1440 x 1080 pixels. Camera: Natus RetCam Envision (130° FOV). Pediatric retinal photograph (wide-field) — 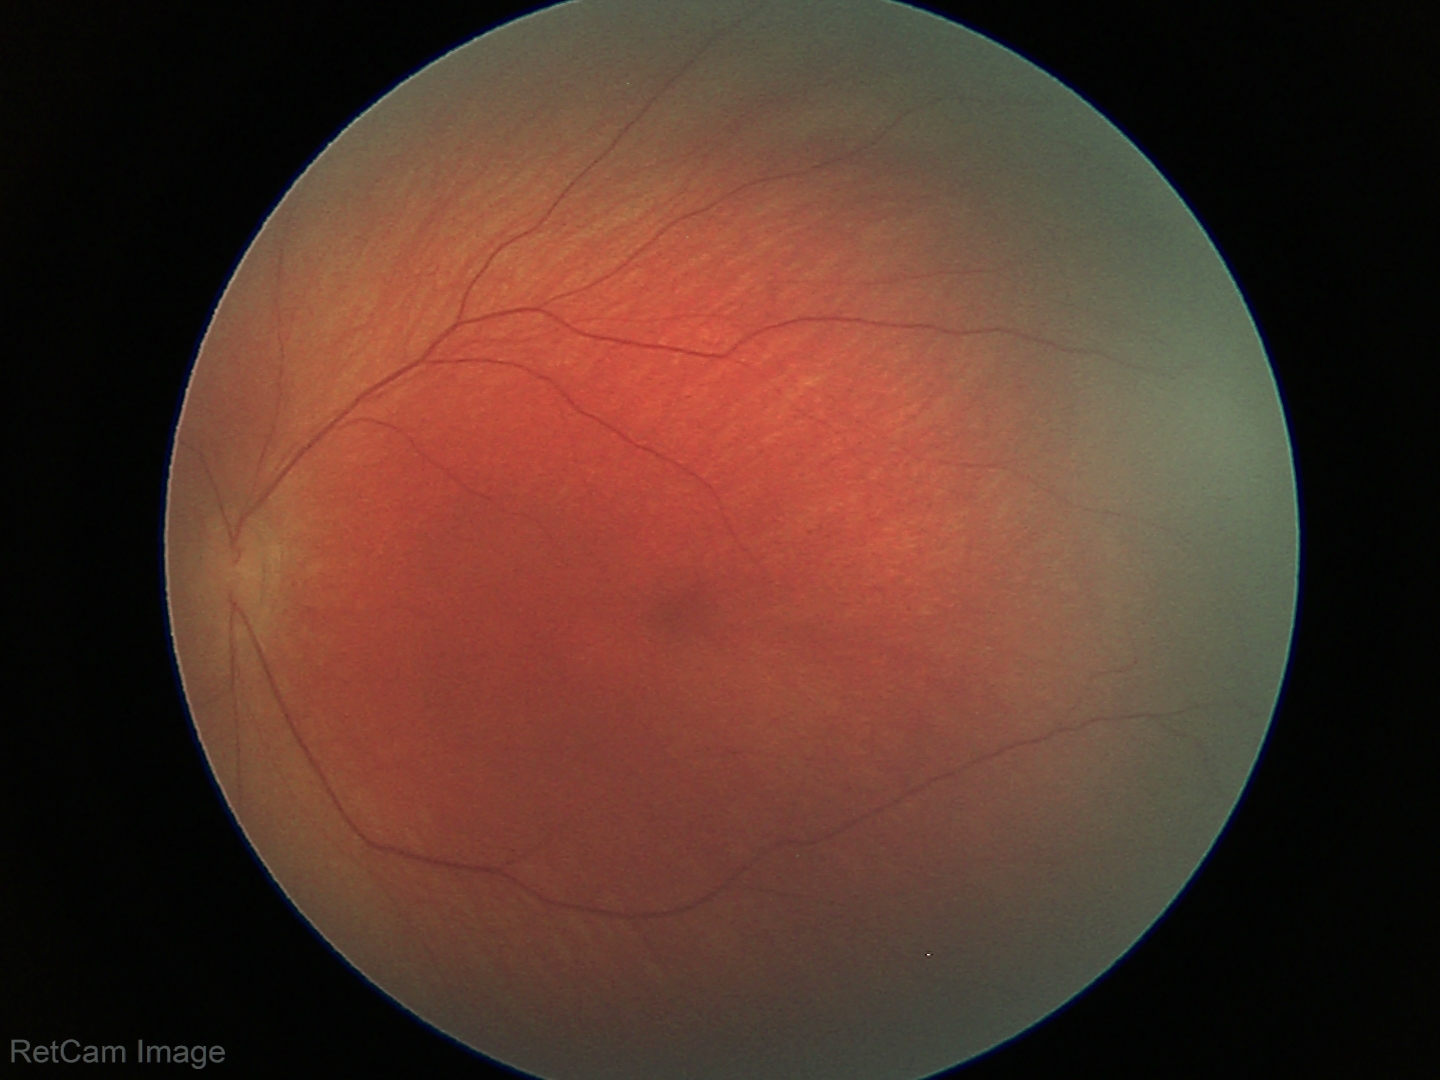 Physiological retinal appearance for postconceptual age.